Mydriatic (tropicamide 0.5%) · 2361x1568: 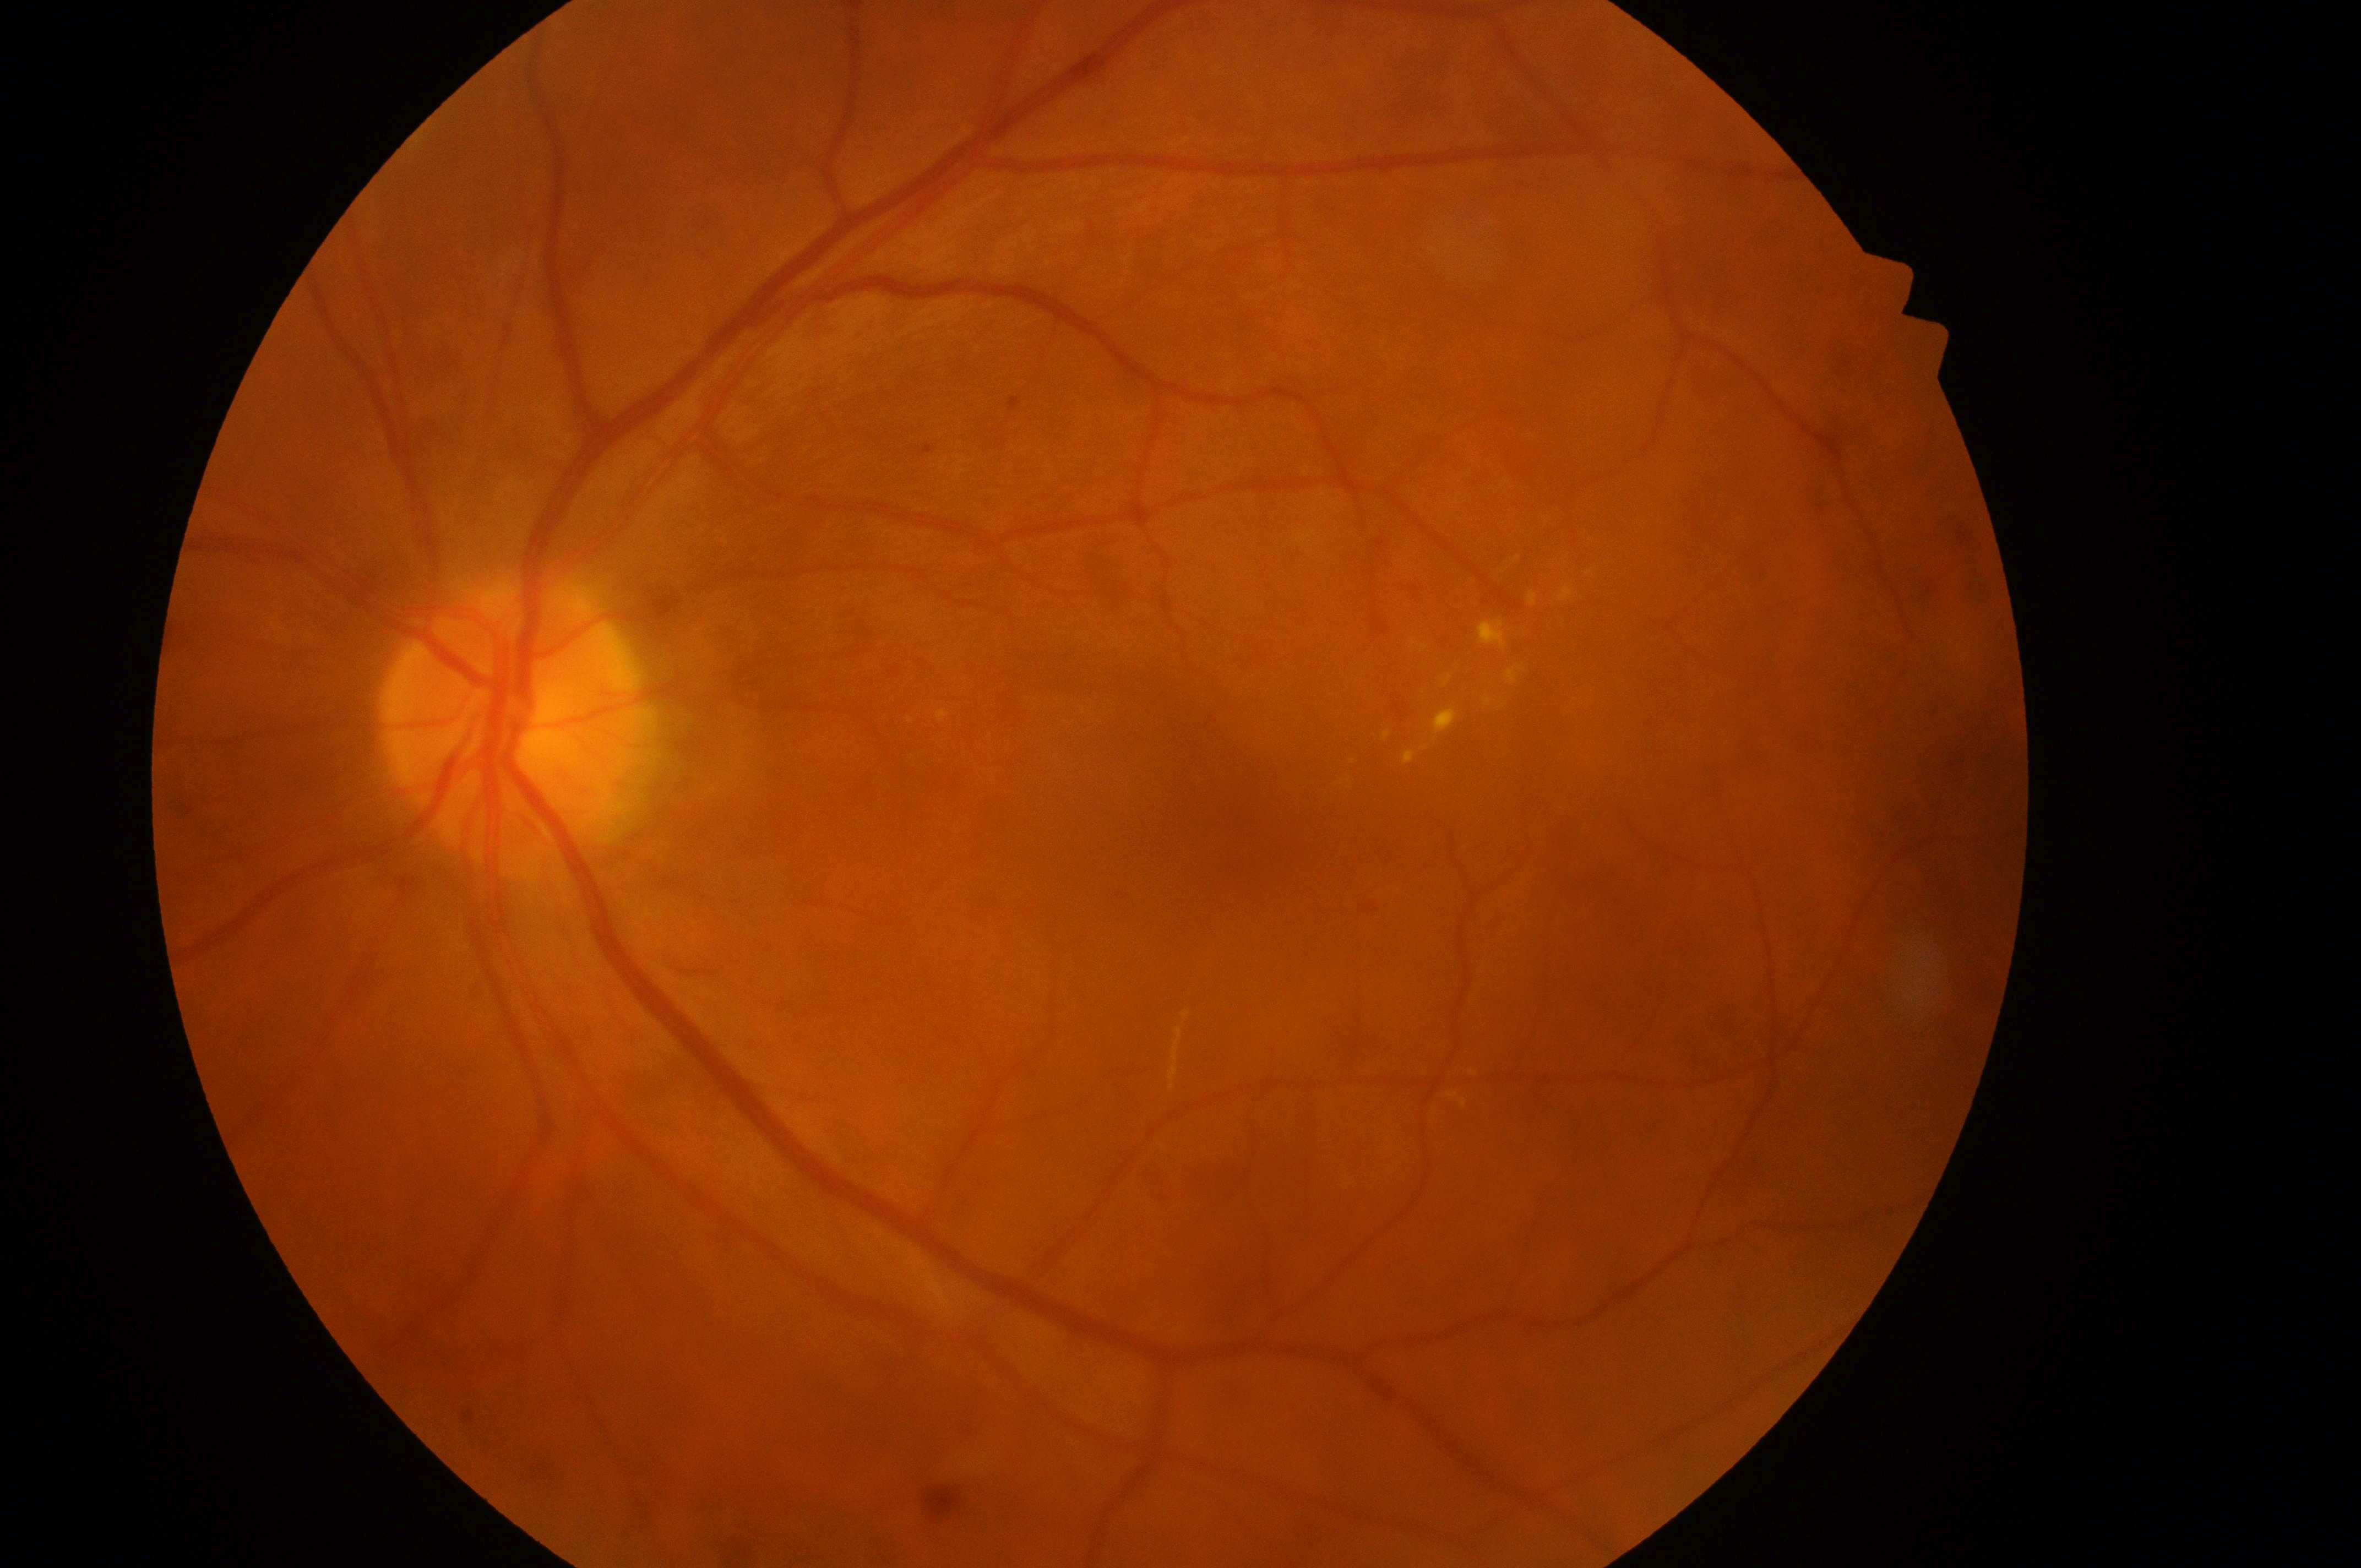
Diabetic retinopathy grade: 2.
Eye: left.
Optic disc: (x=507, y=729).
Macular edema: 2.
Macular center located at (x=1233, y=826).